45° FOV: 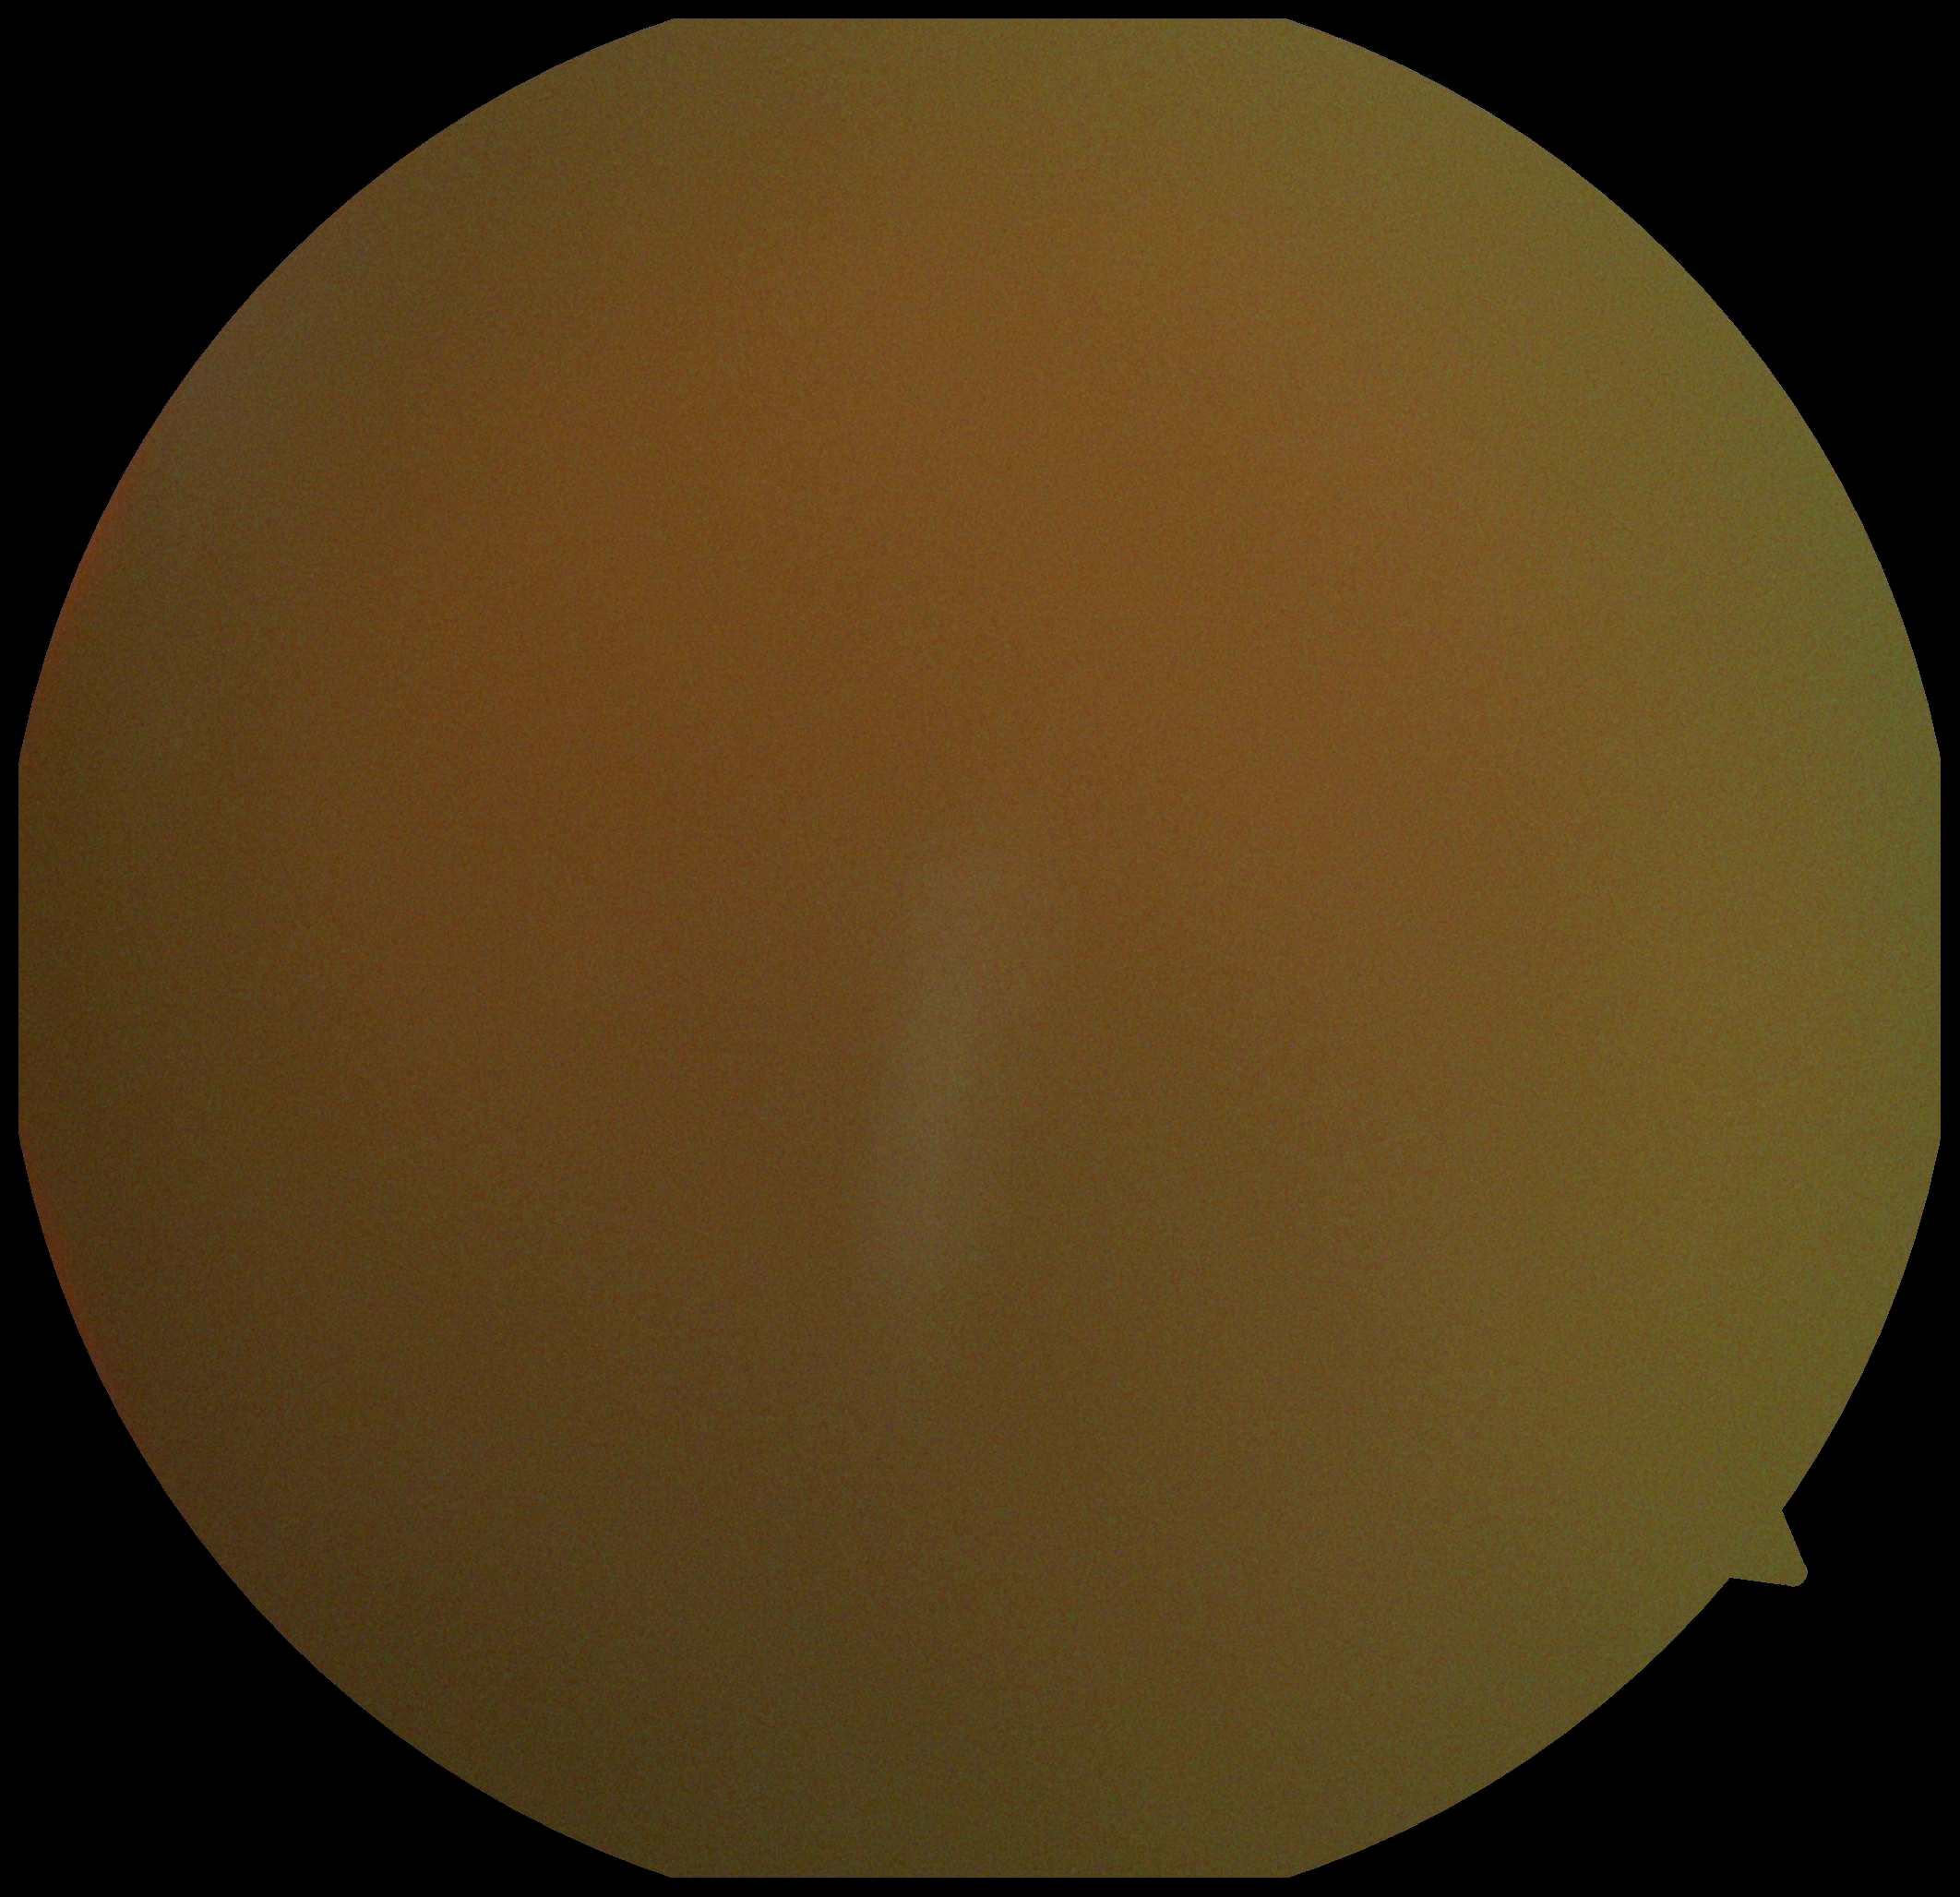 DR is ungradable.
The image cannot be graded for diabetic retinopathy.